45 degree fundus photograph, NIDEK AFC-230, without pupil dilation:
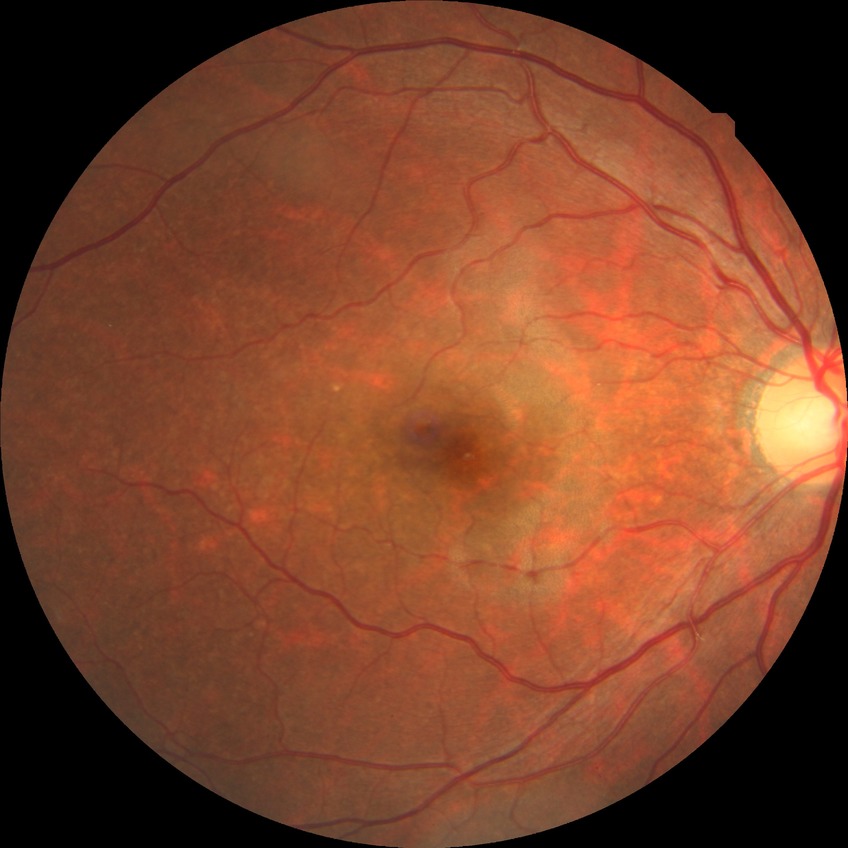

Diabetic retinopathy (DR): no diabetic retinopathy (NDR).